Tabletop color fundus camera image:
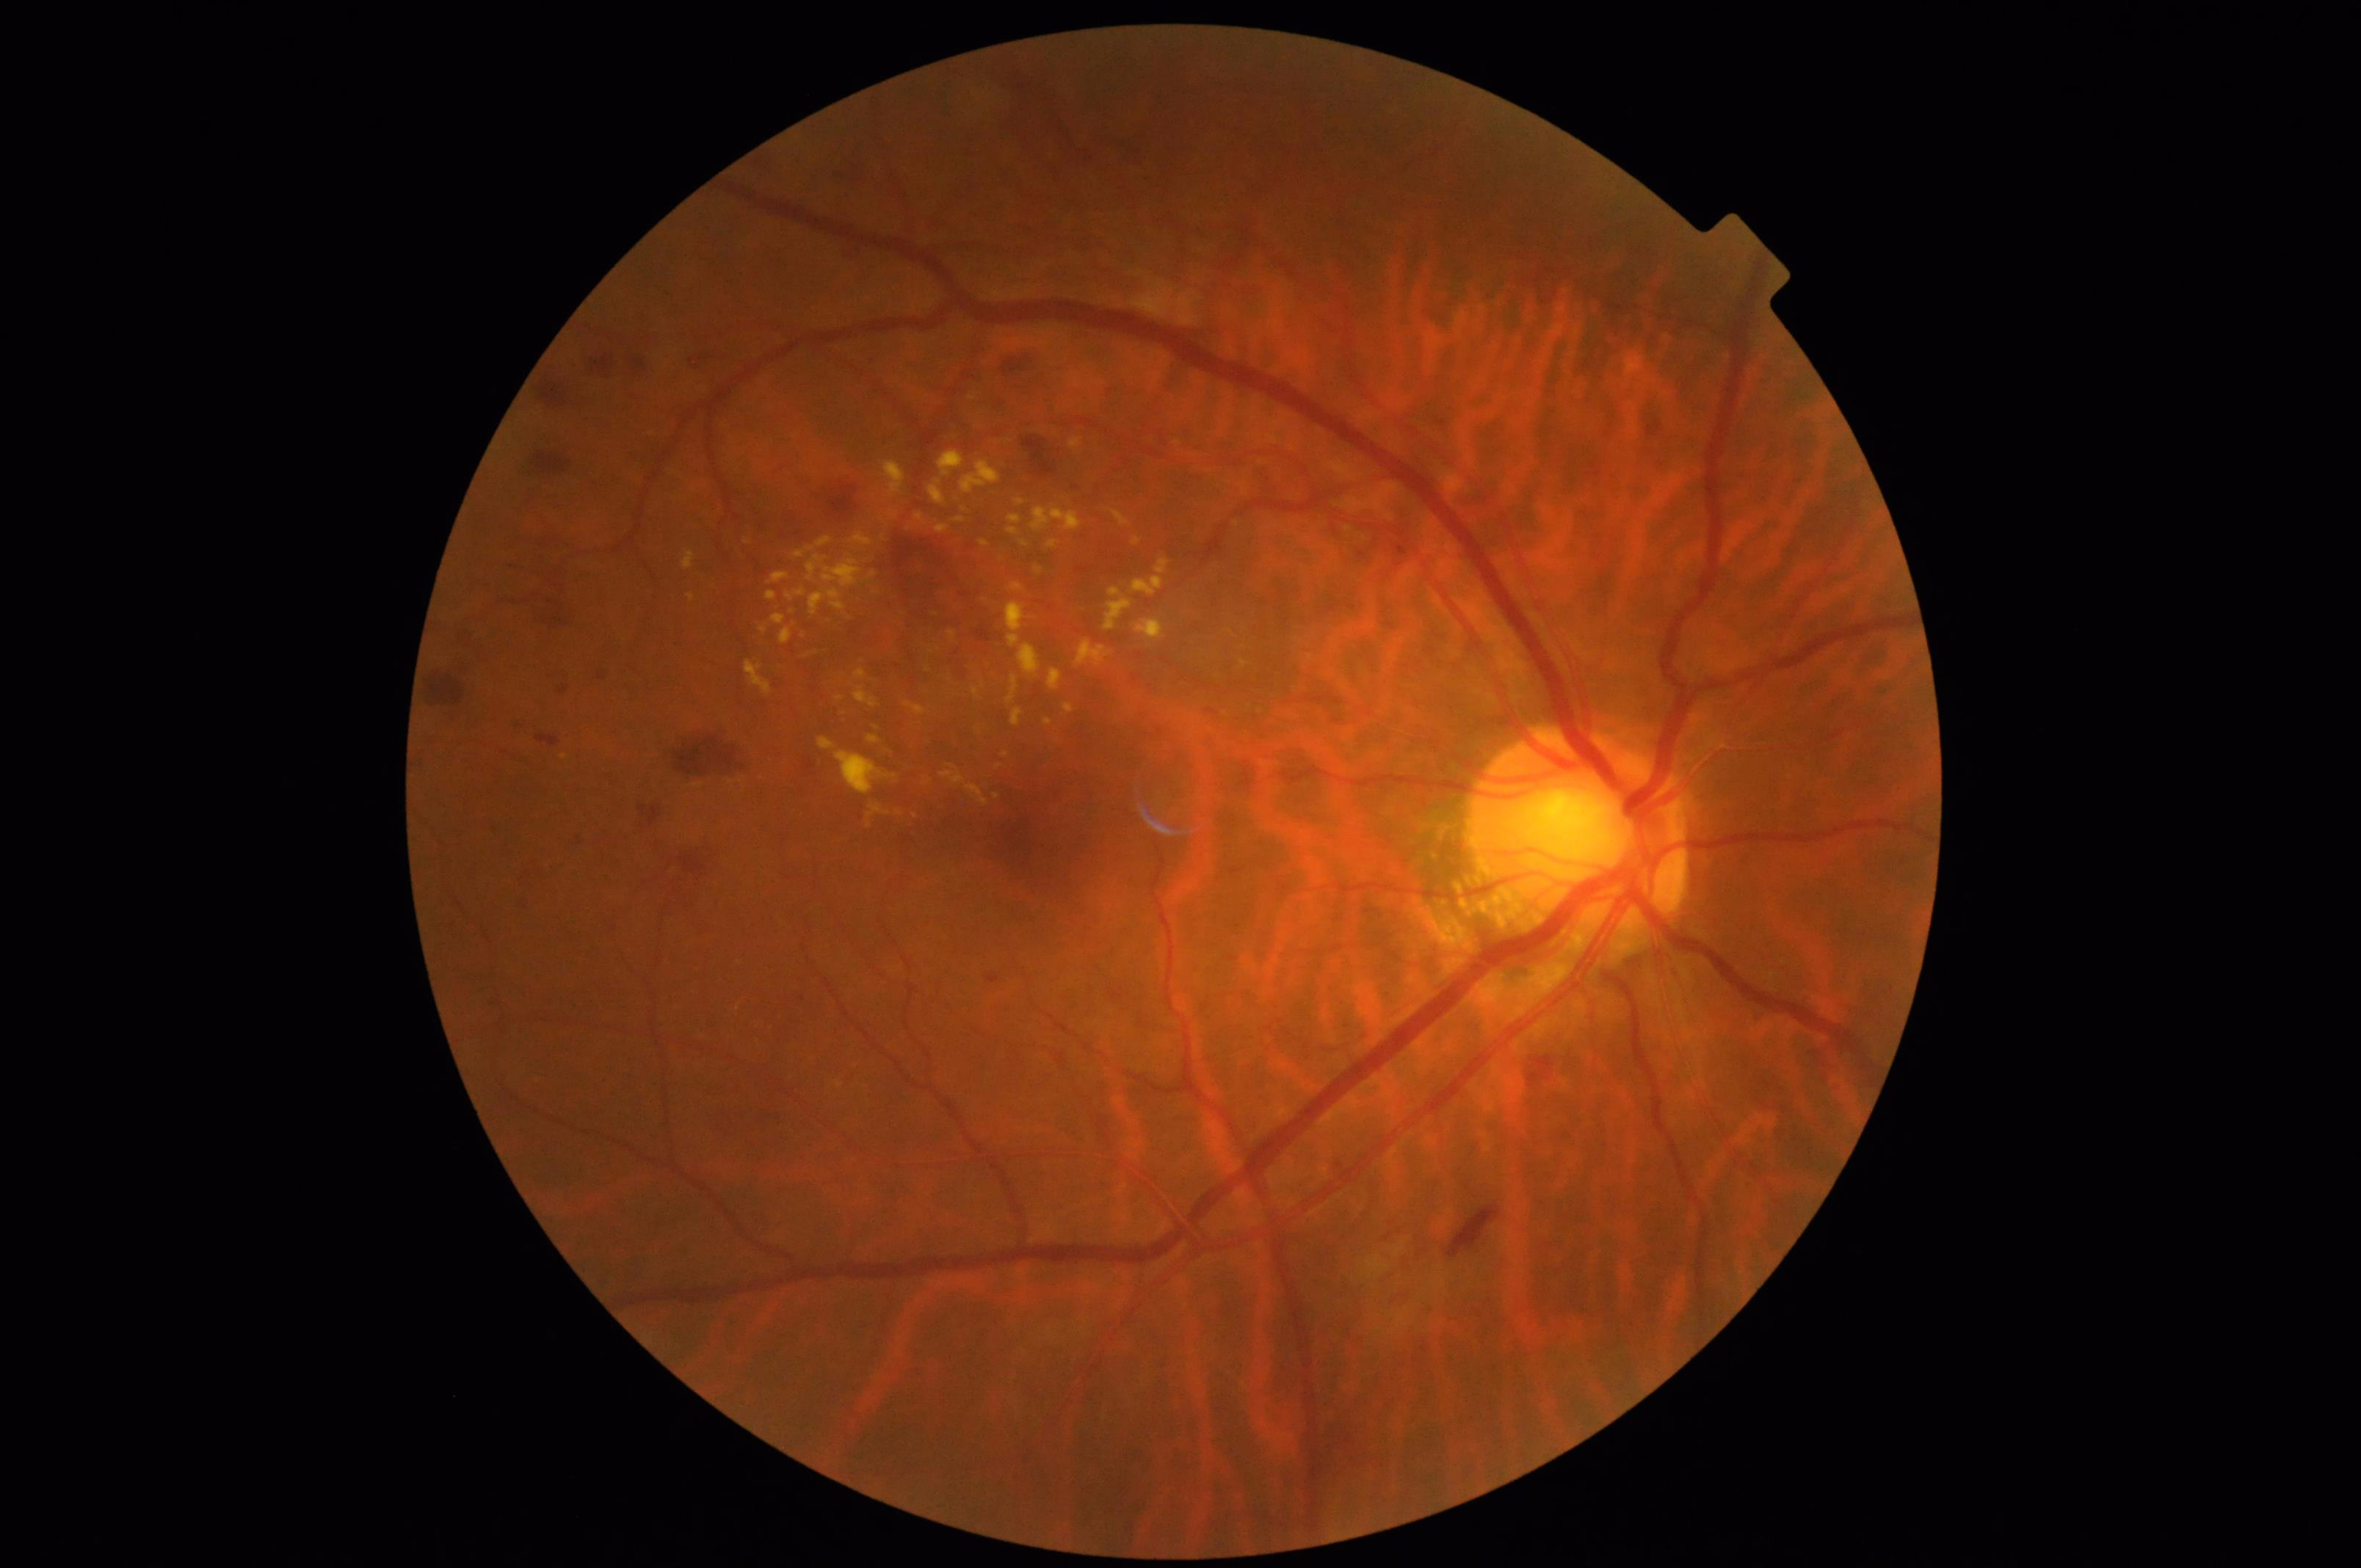
Contrast = satisfactory
Overall image quality = acceptable
Sharpness = good
Illumination = satisfactory